Wide-field fundus image from infant ROP screening: 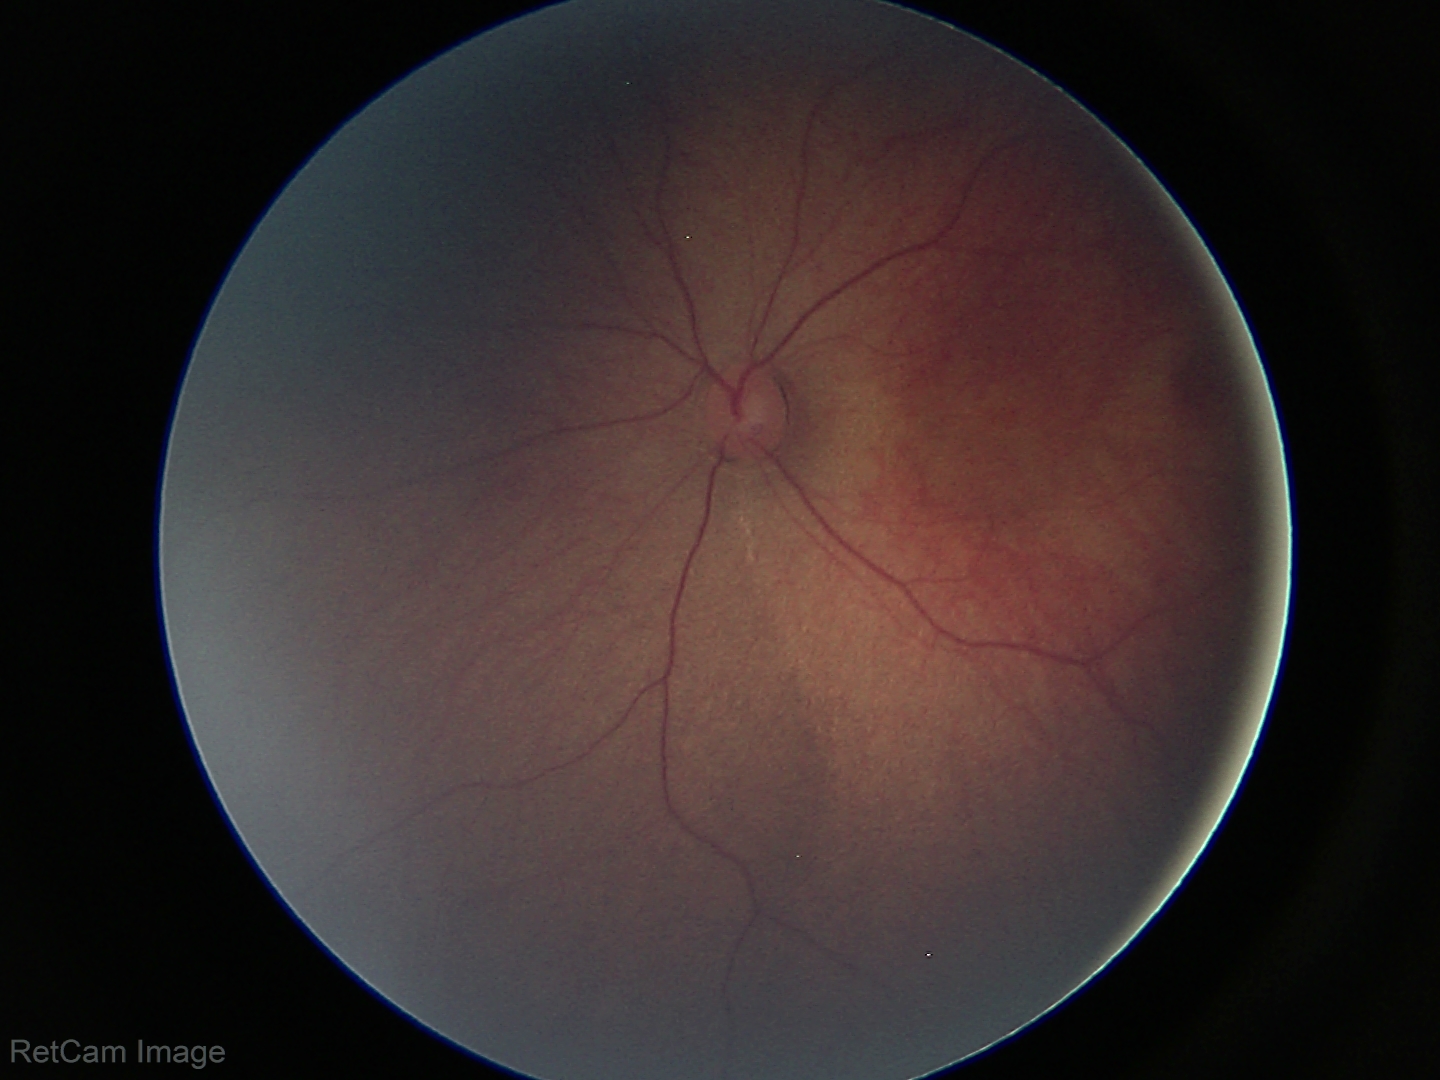 Screening: physiological appearance with no retinal pathology.